45-degree field of view.
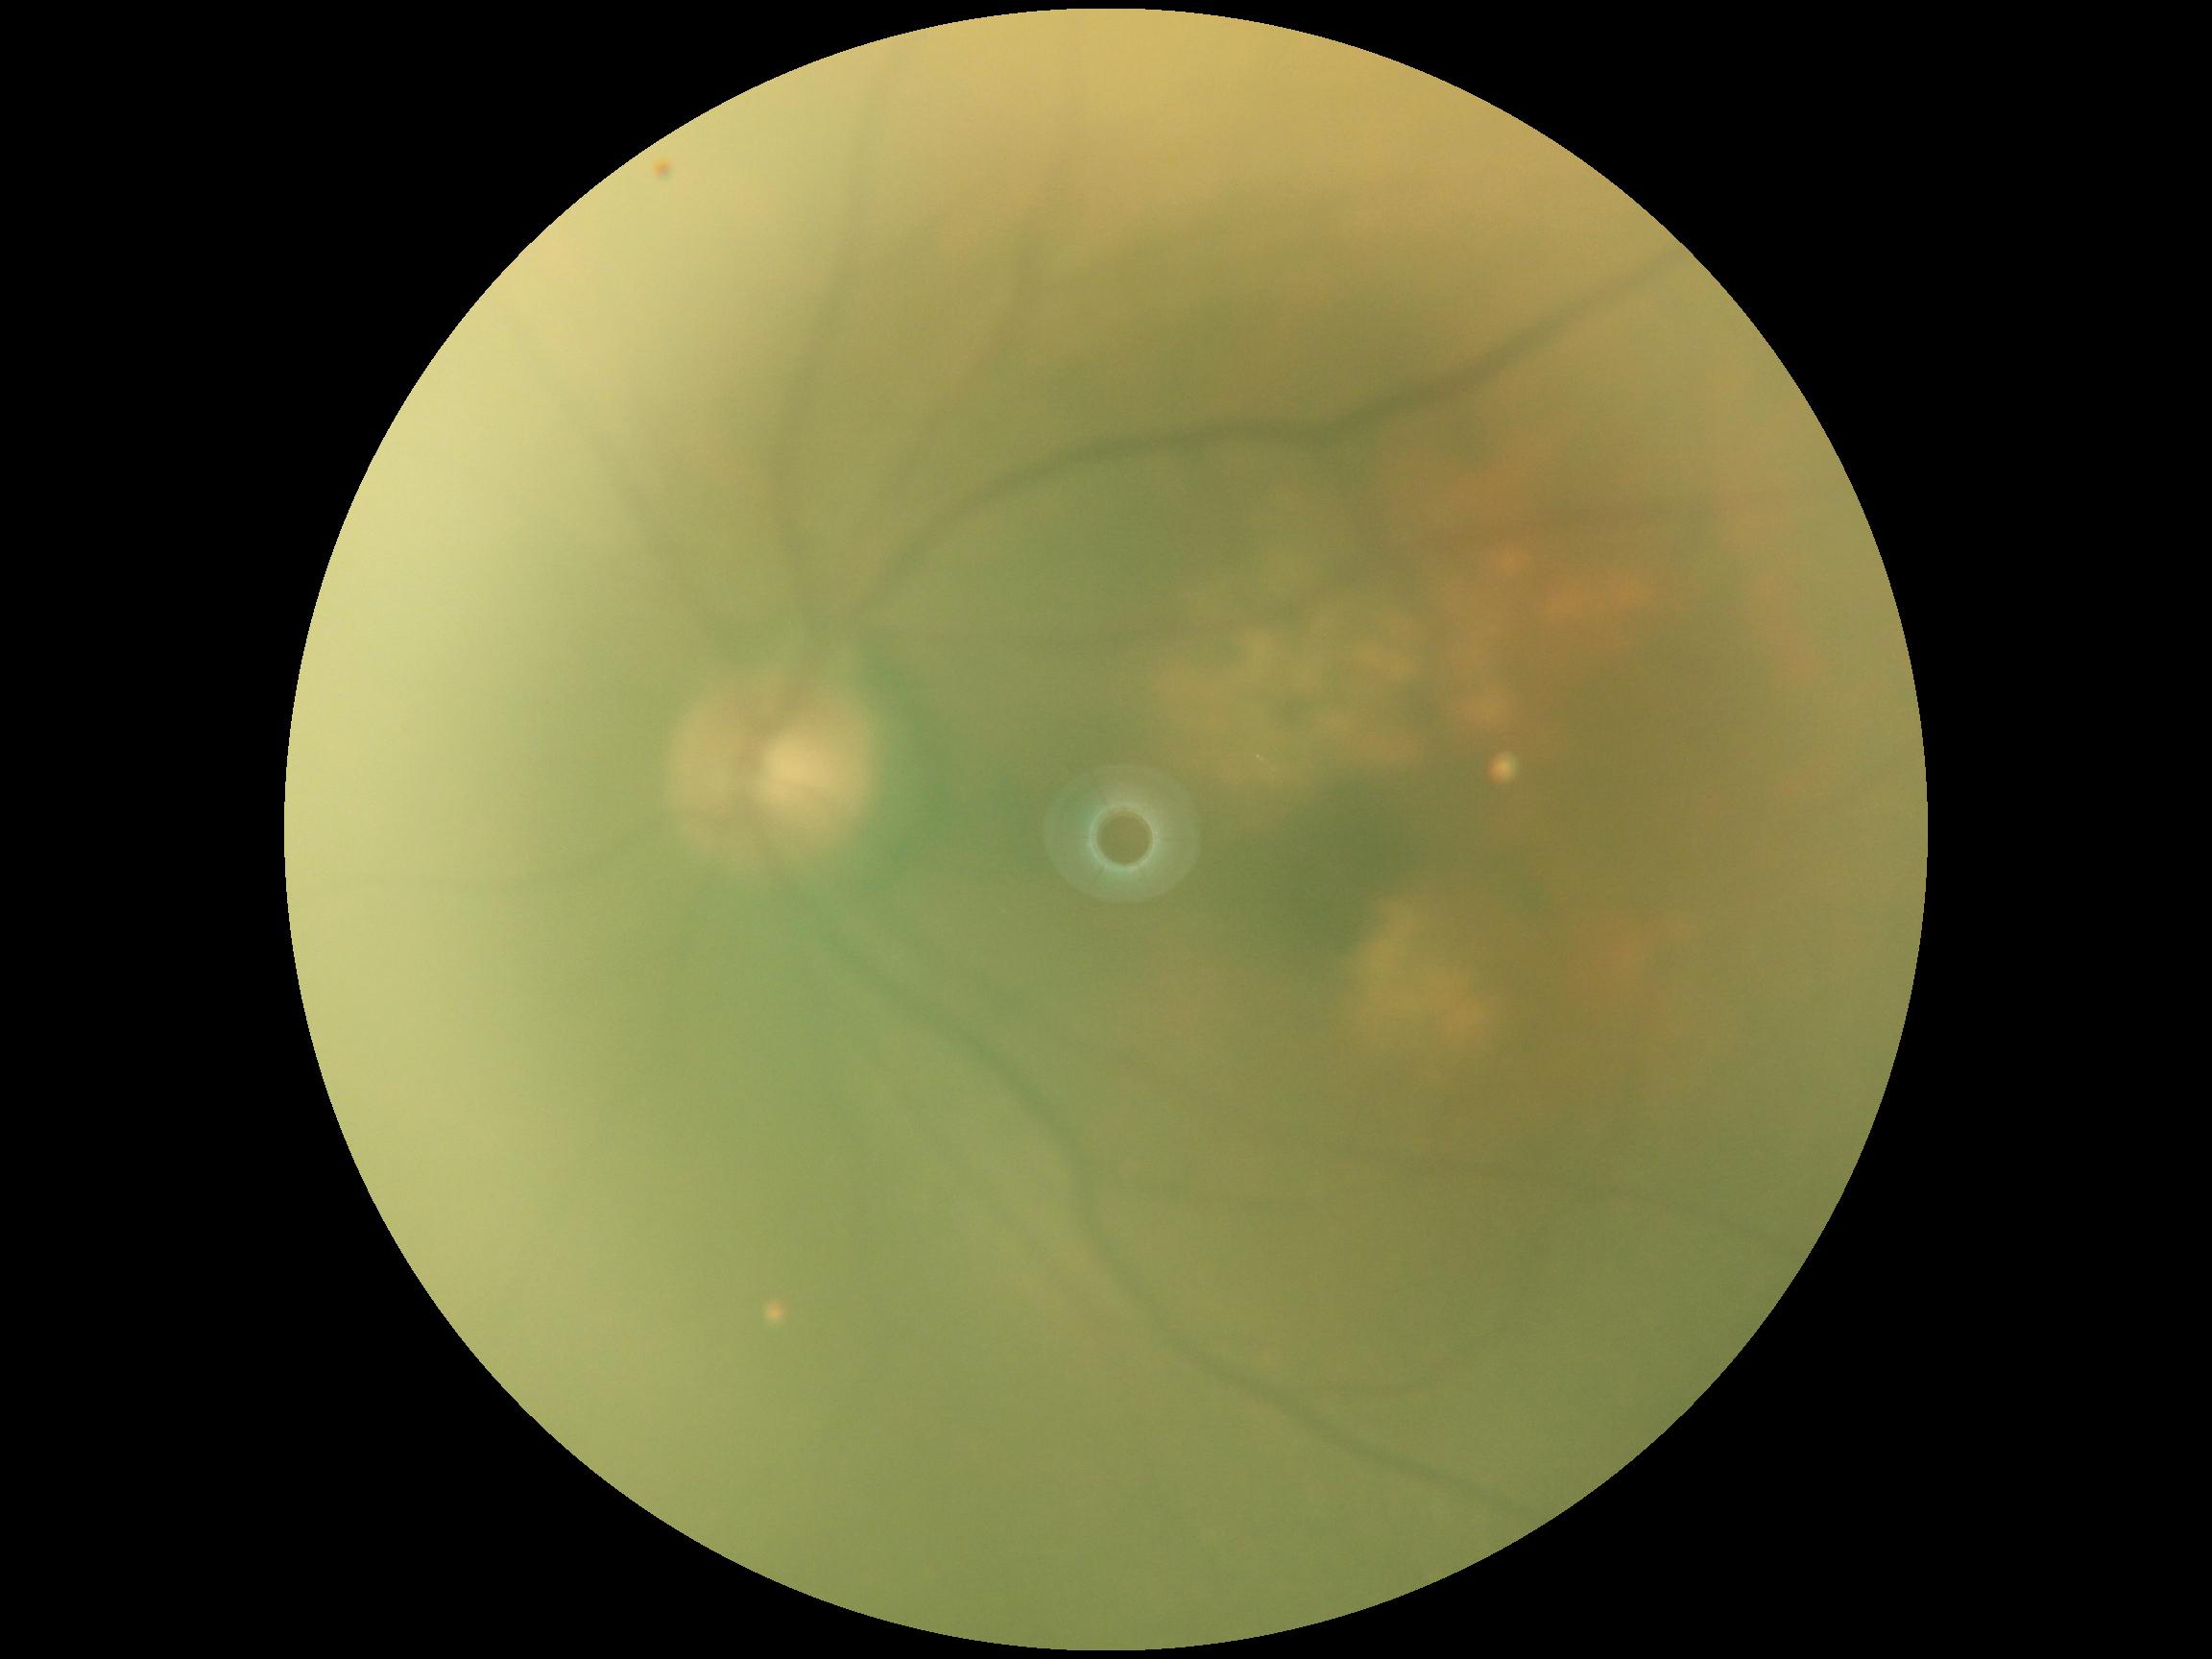

Retinopathy is ungradable due to poor image quality.